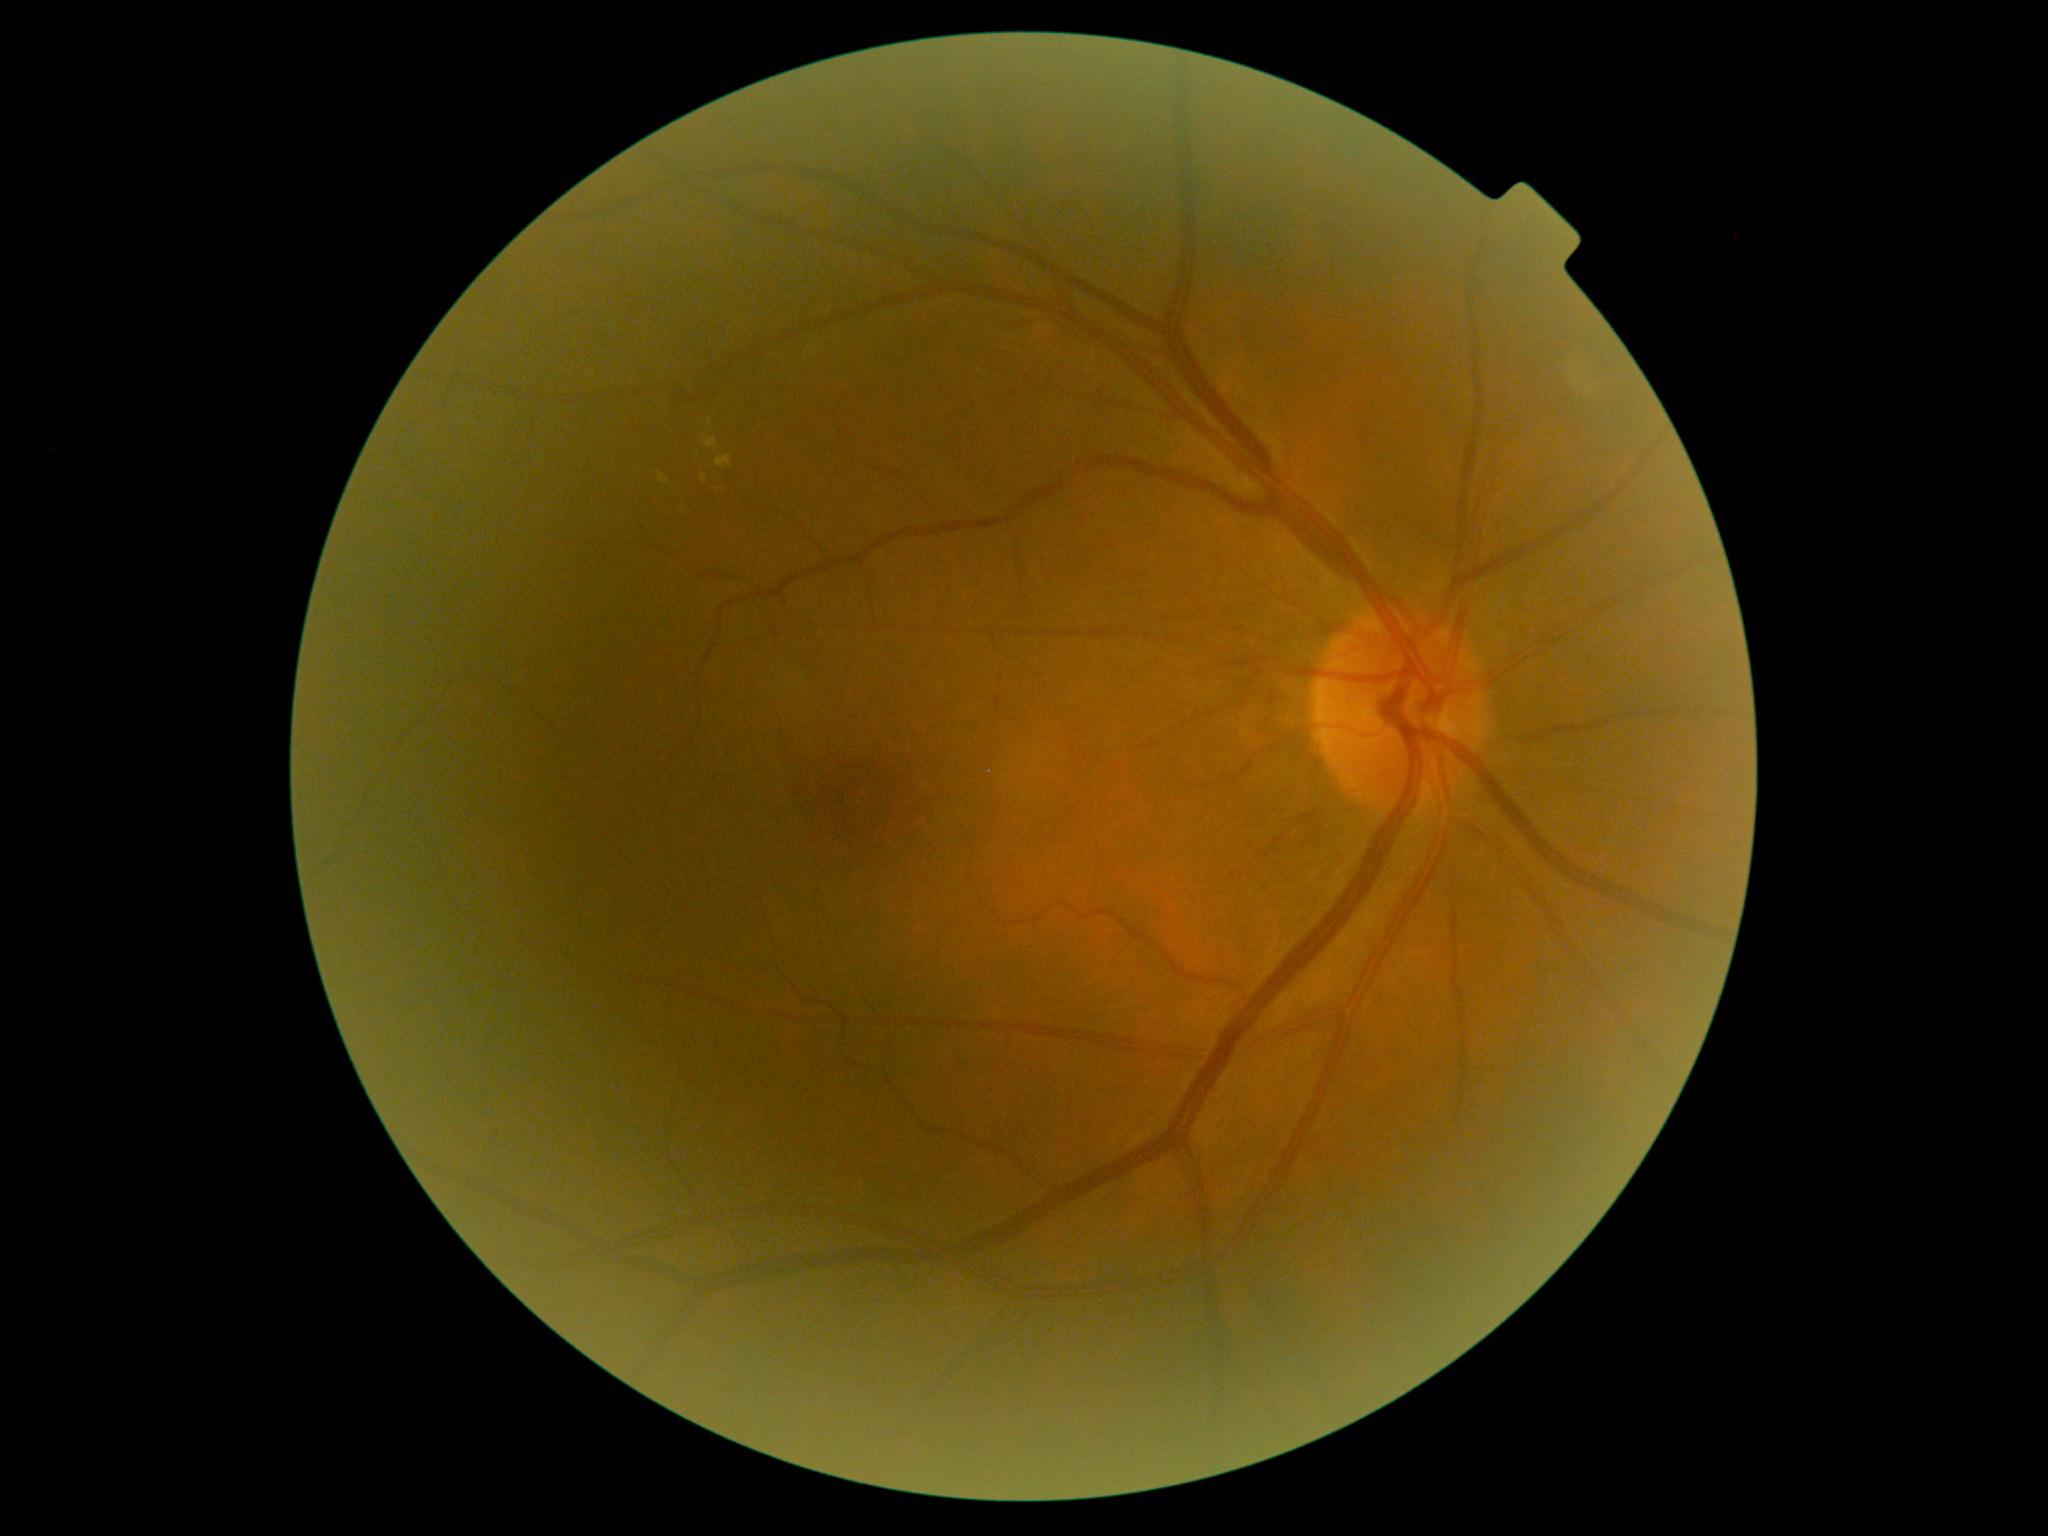 DR: grade 2 (moderate NPDR).